Image size 640x480 · pediatric wide-field fundus photograph
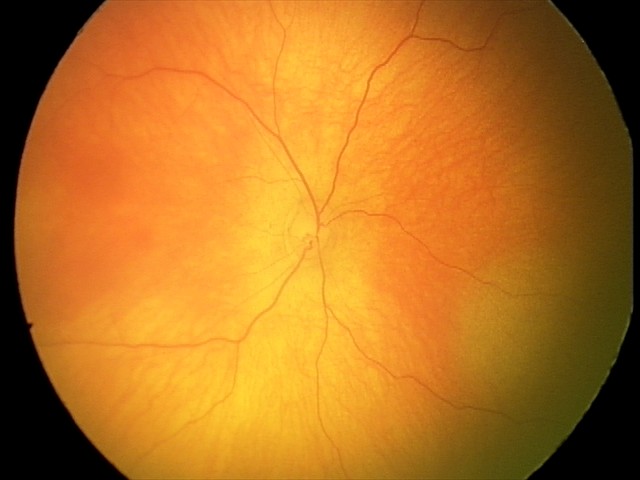 Screening diagnosis: no abnormalities.